45° field of view:
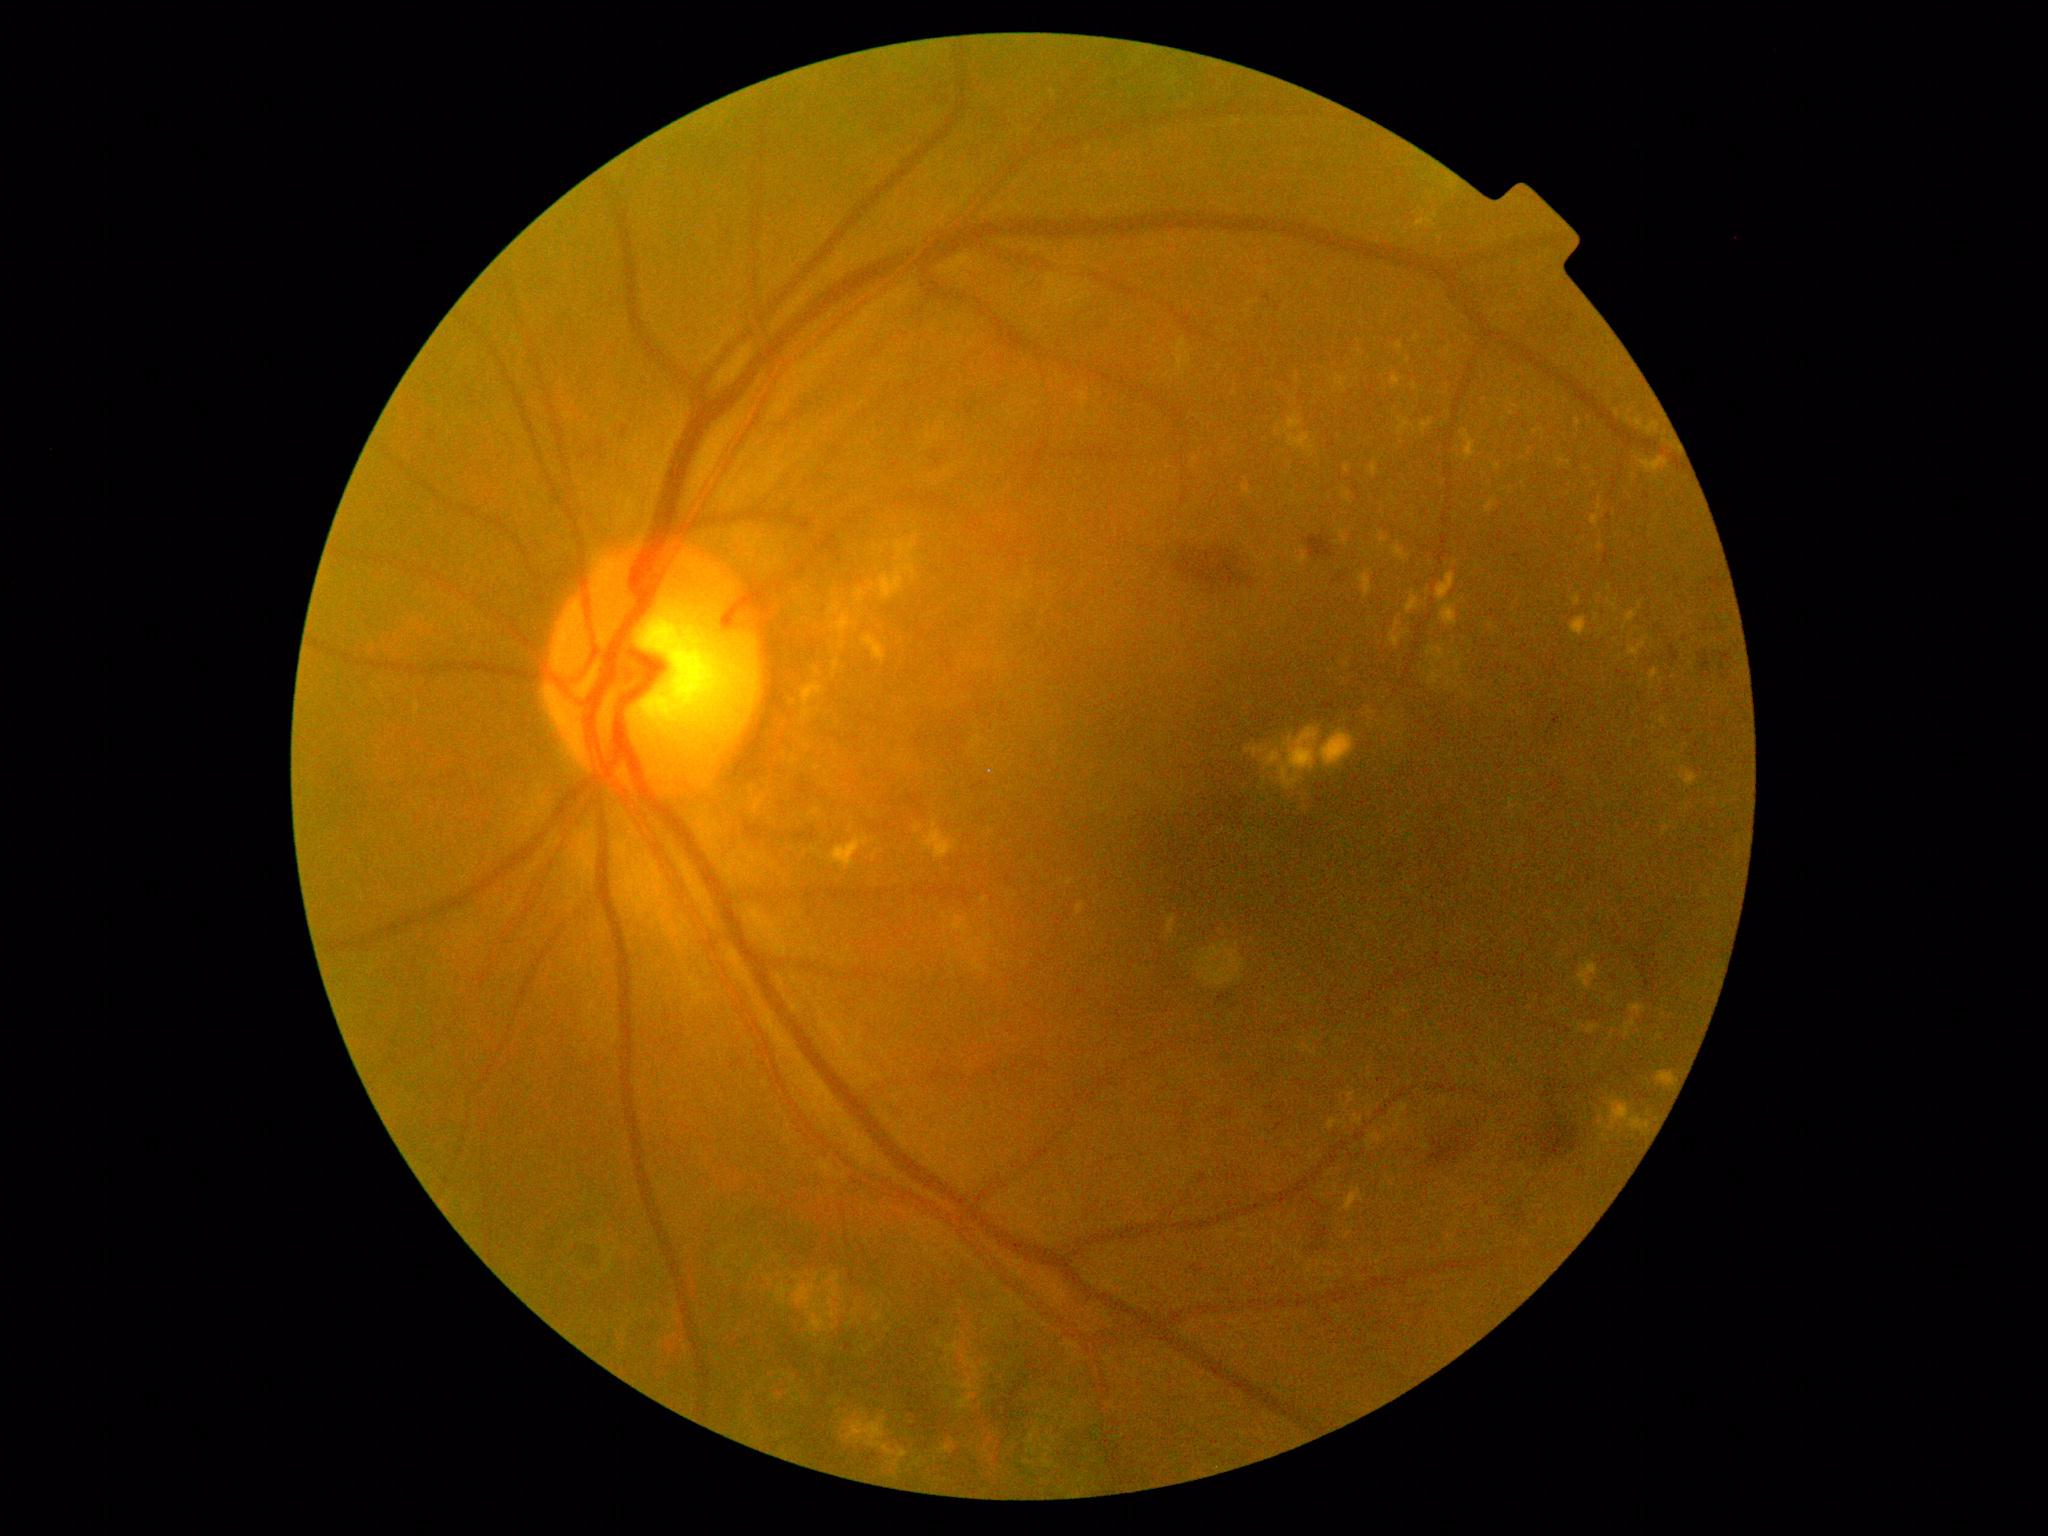 Retinopathy: 2
Representative lesions:
- hard exudates (continued): 914 823 923 833; 812 667 822 679; 1416 218 1437 229; 1576 961 1600 989; 1378 531 1388 546; 923 821 959 860; 1390 375 1403 389; 1615 410 1620 418; 1441 604 1459 627; 1288 412 1302 431; 1625 411 1632 422; 1626 610 1638 624; 1344 1187 1364 1213; 1245 745 1269 758
- Additional small hard exudates near (1414; 387); (1408; 361); (984; 900); (875; 548)